Image size 2352x1568 — 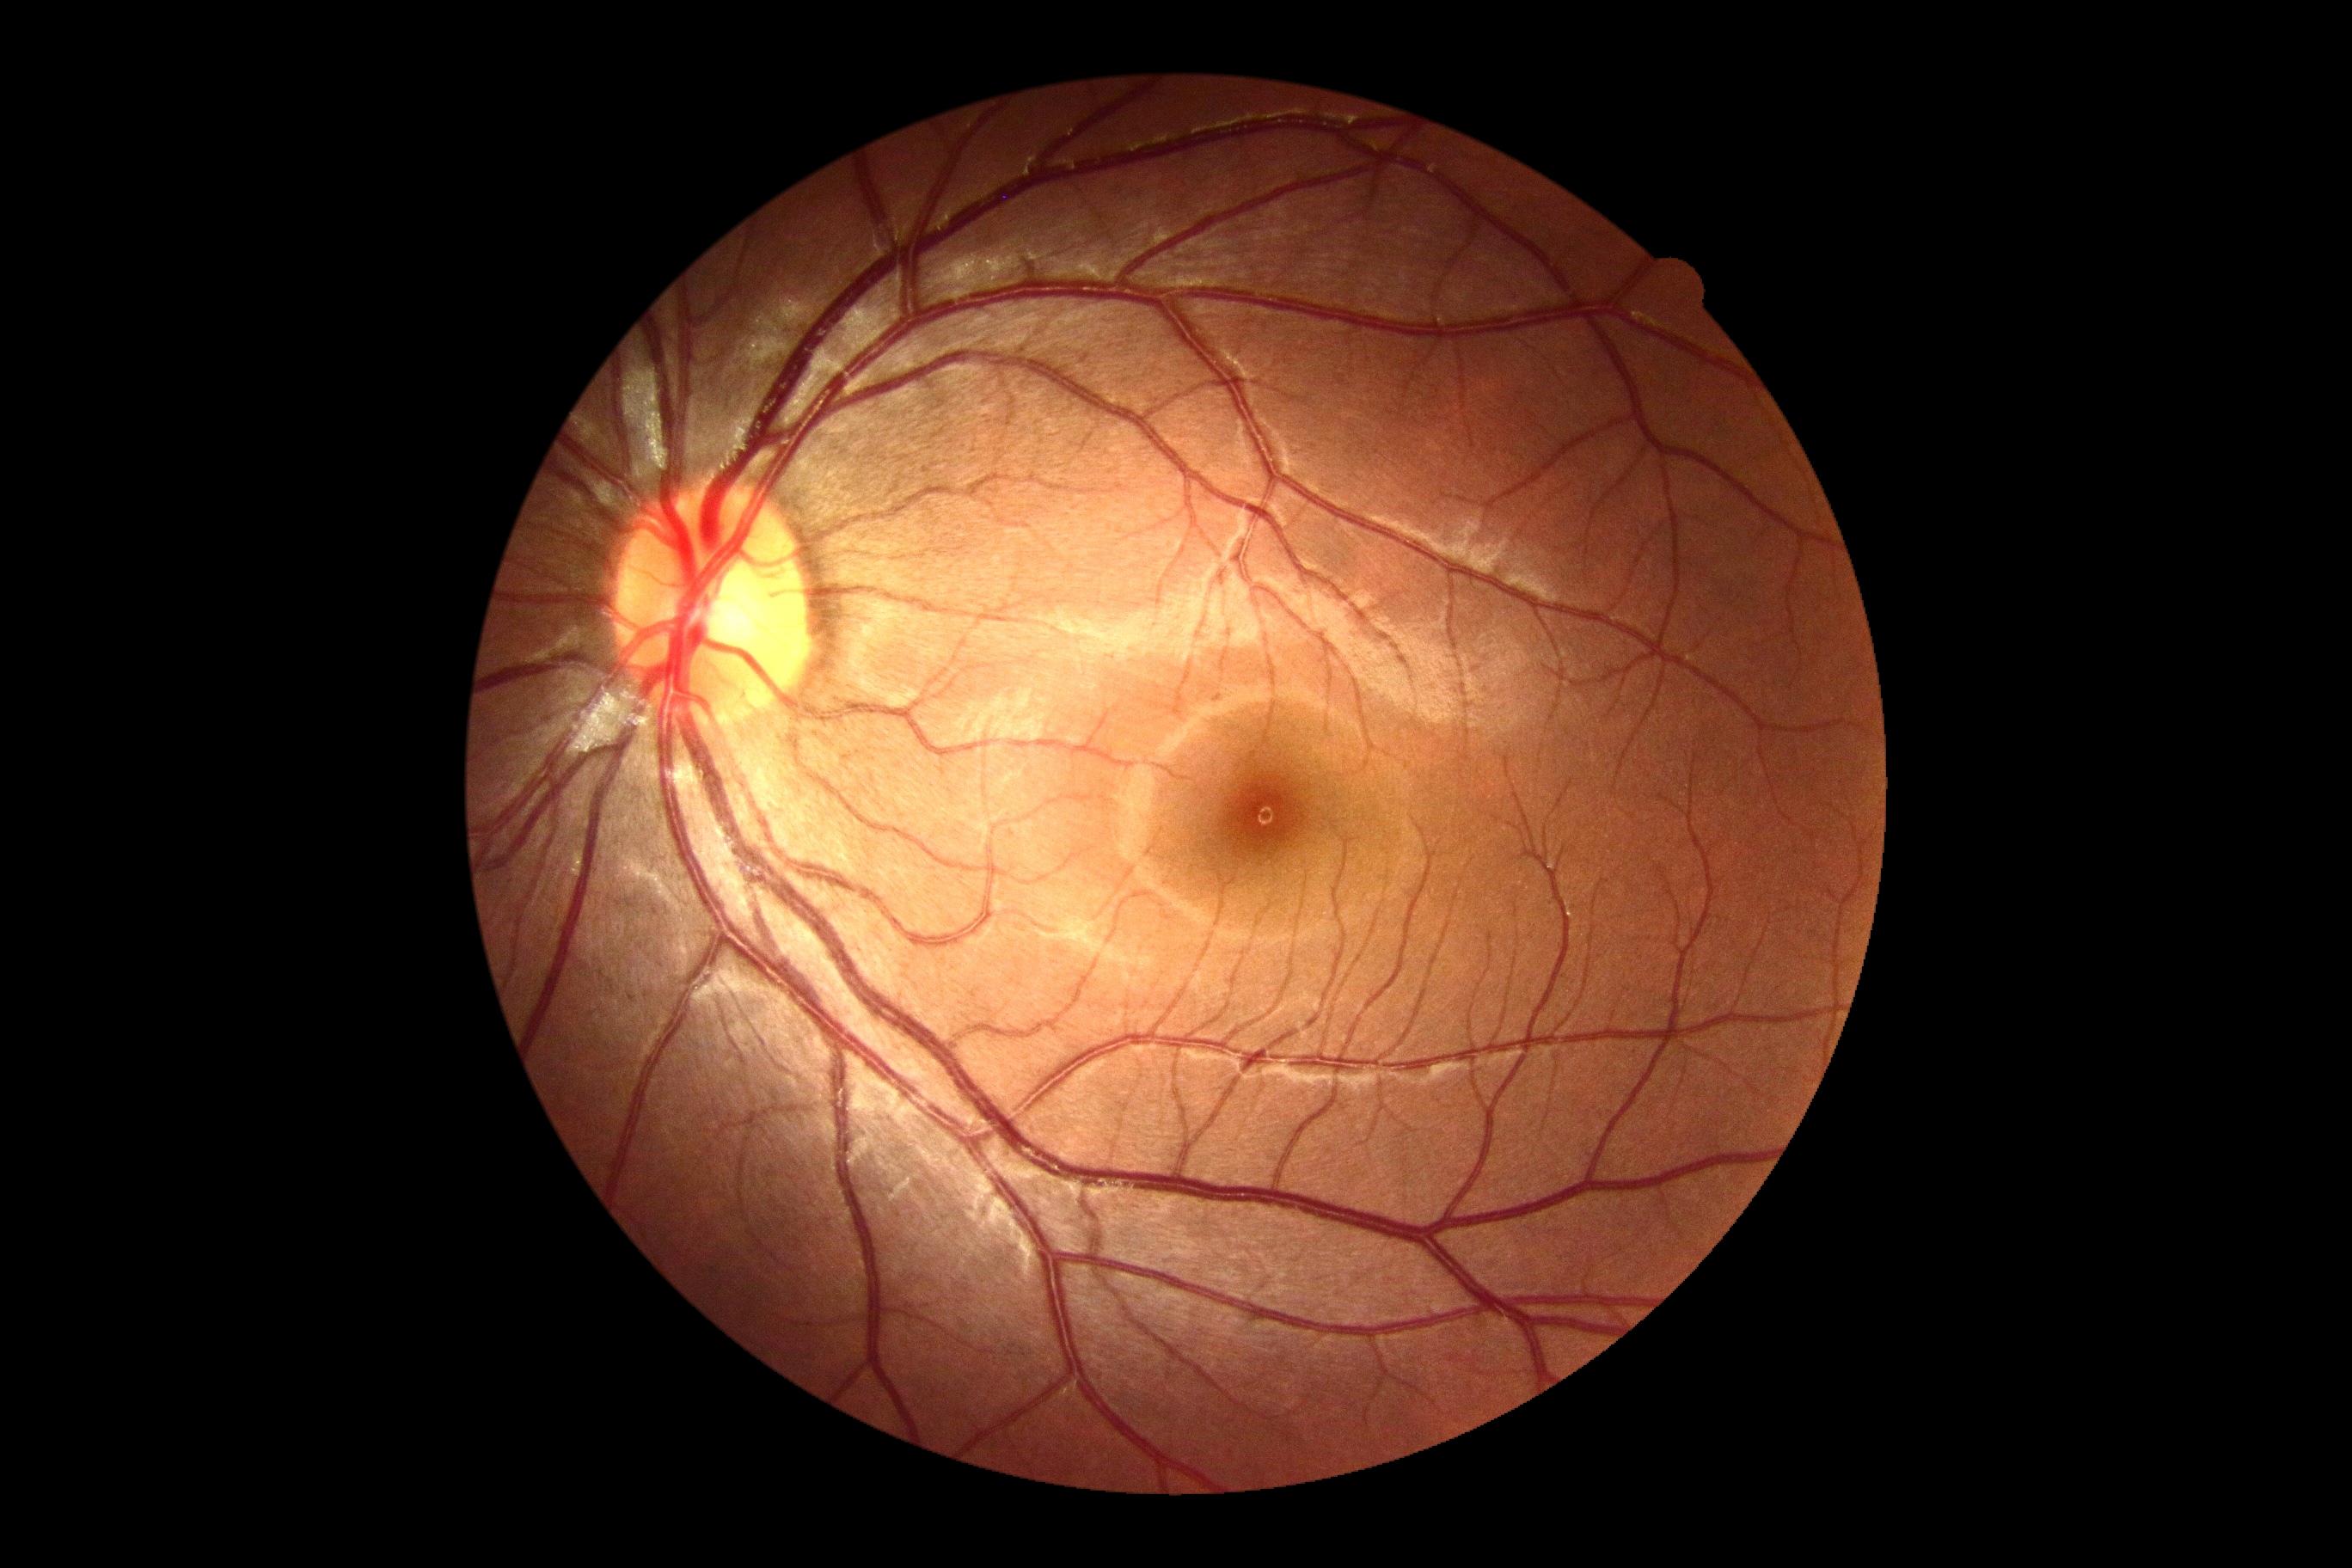
DR grade = 0